RetCam wide-field infant fundus image · image size 640x480 — 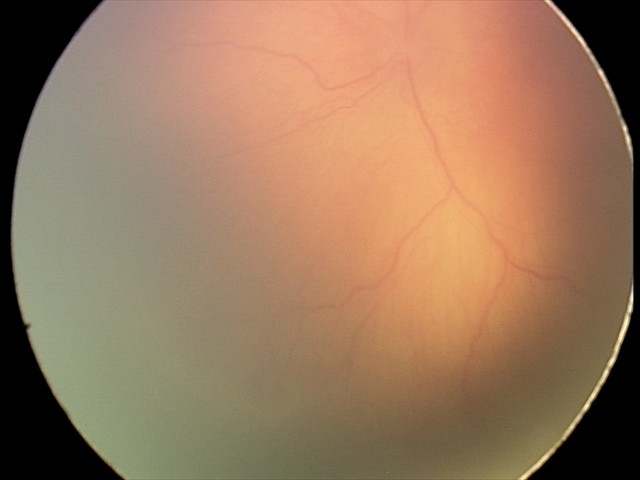
No plus disease.
Diagnosis from this screening exam: retinopathy of prematurity stage 1.